CFP:
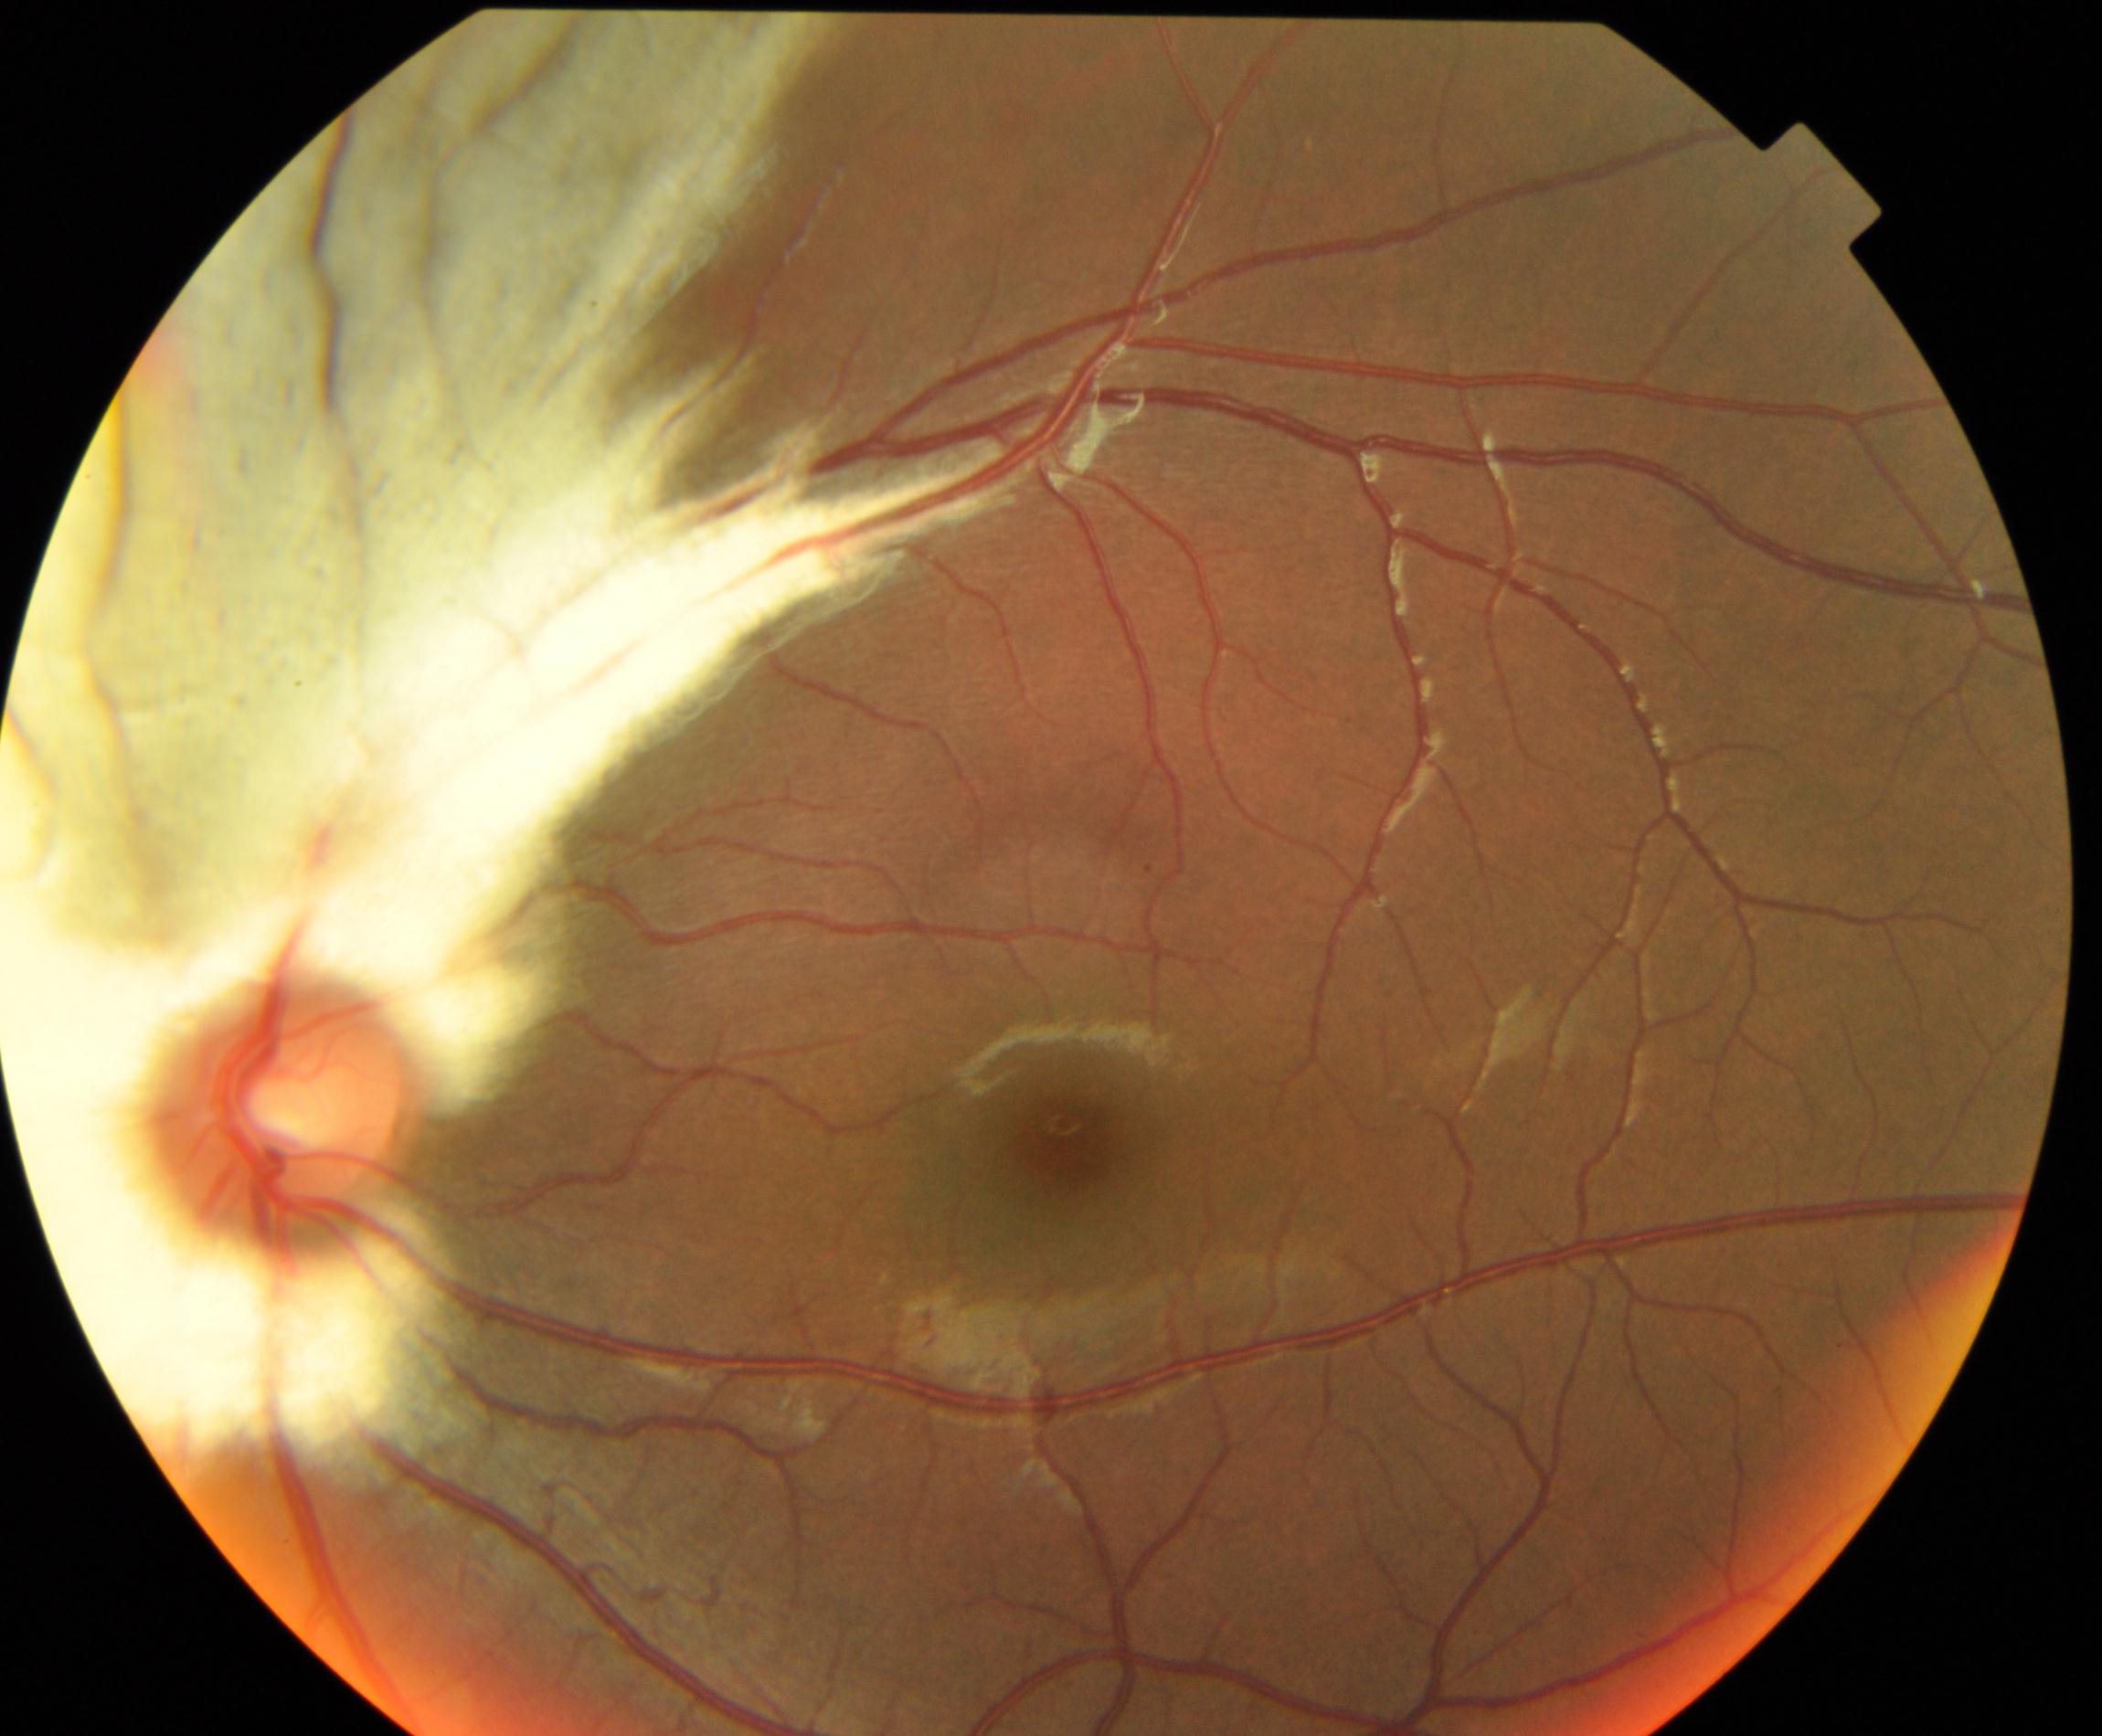 Impression: myelinated nerve fibers.